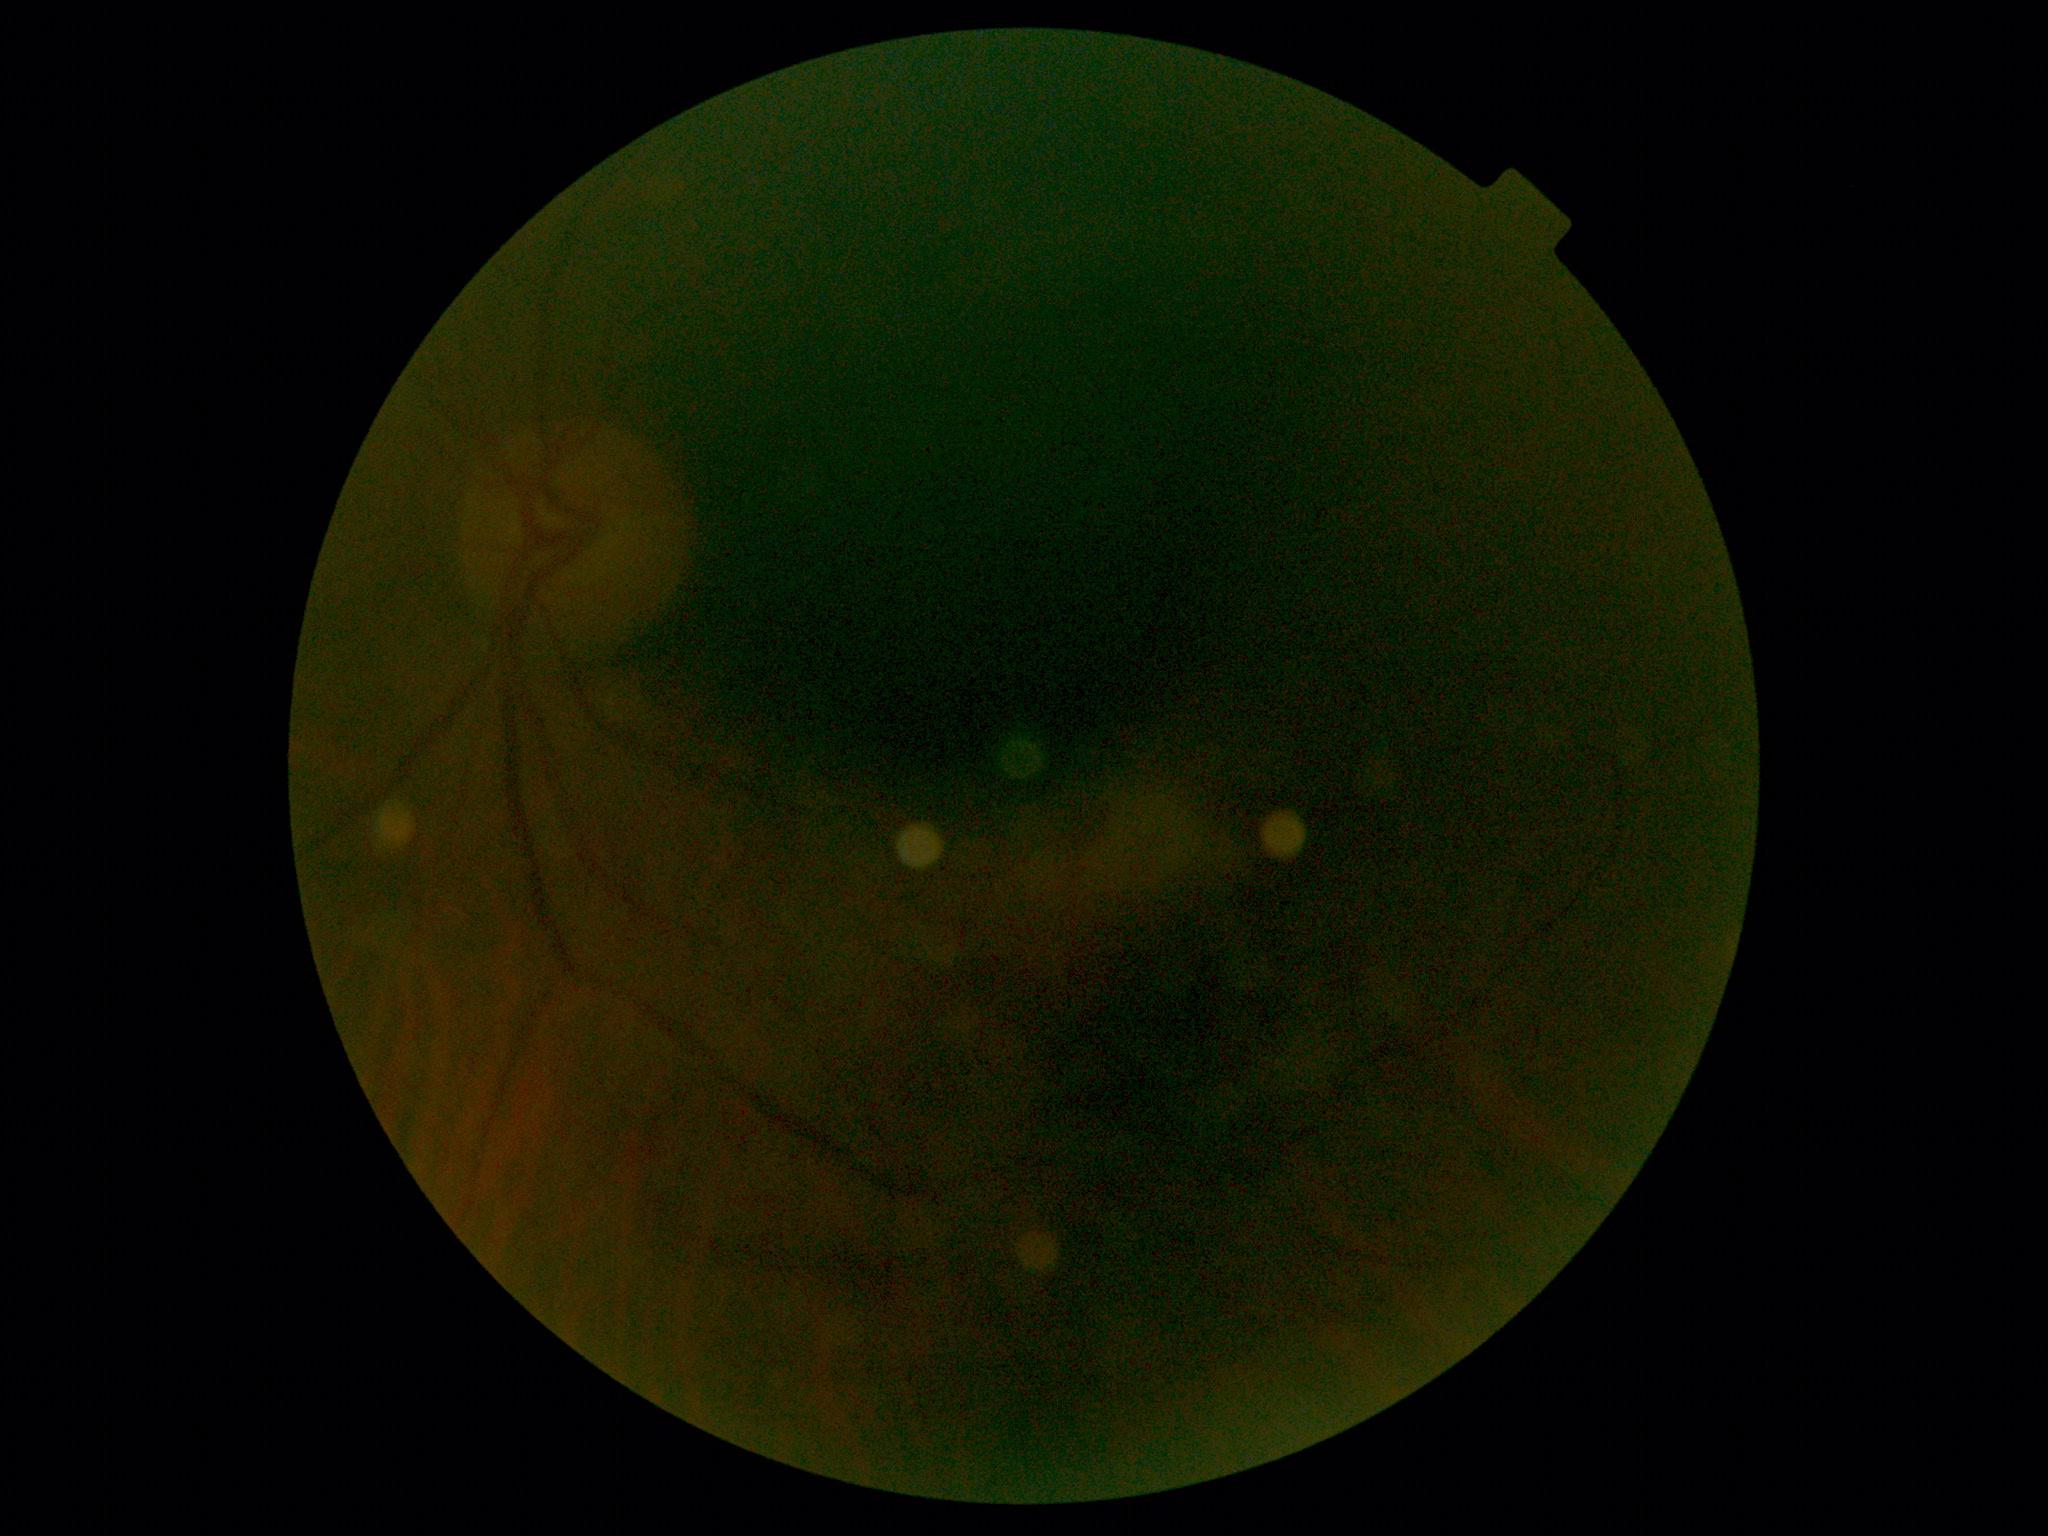
Image quality is insufficient for diabetic retinopathy assessment. Diabetic retinopathy (DR): ungradable due to poor image quality.